Clarity RetCam 3, 130° FOV; pediatric wide-field fundus photograph
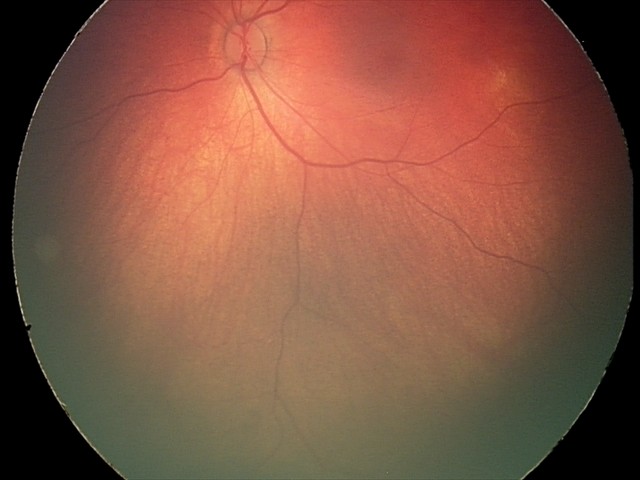

Diagnosis from this screening exam: retinal hemorrhages.